Graded on the modified Davis scale. Without pupil dilation — 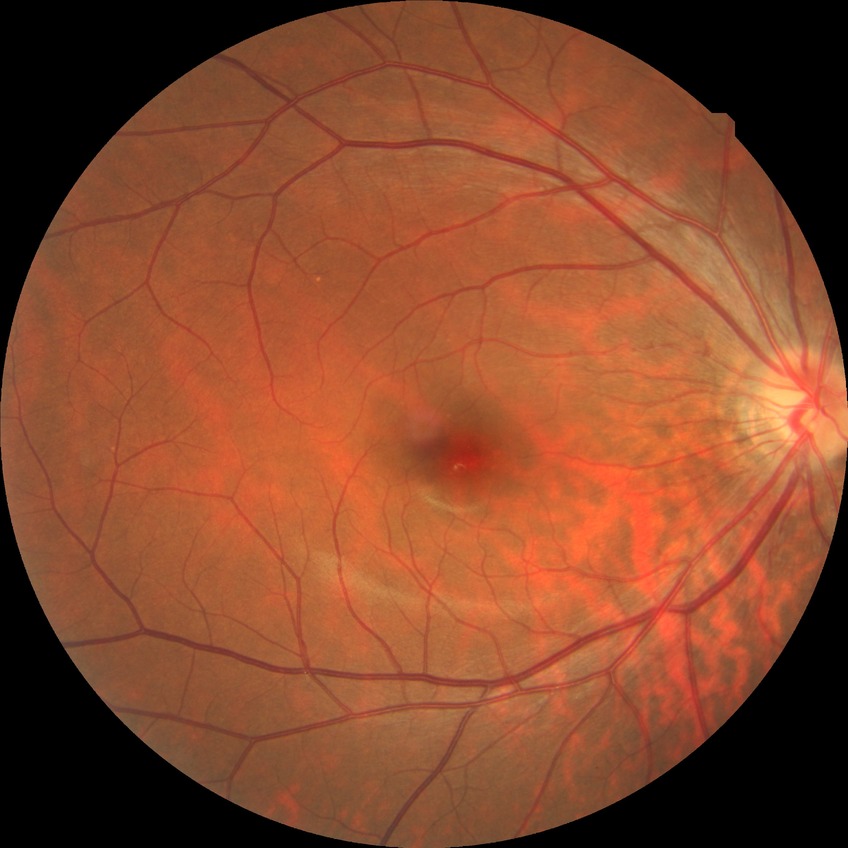
Diabetic retinopathy stage is no diabetic retinopathy.